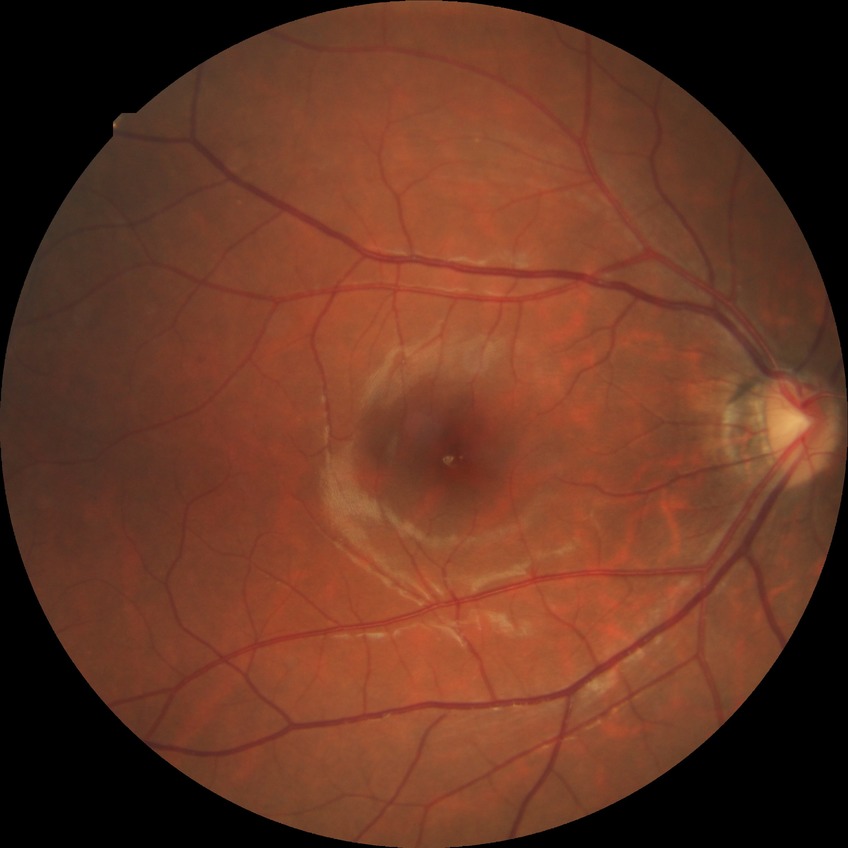 Davis DR grade: NDR.